2352 by 1568 pixels · 45° FOV
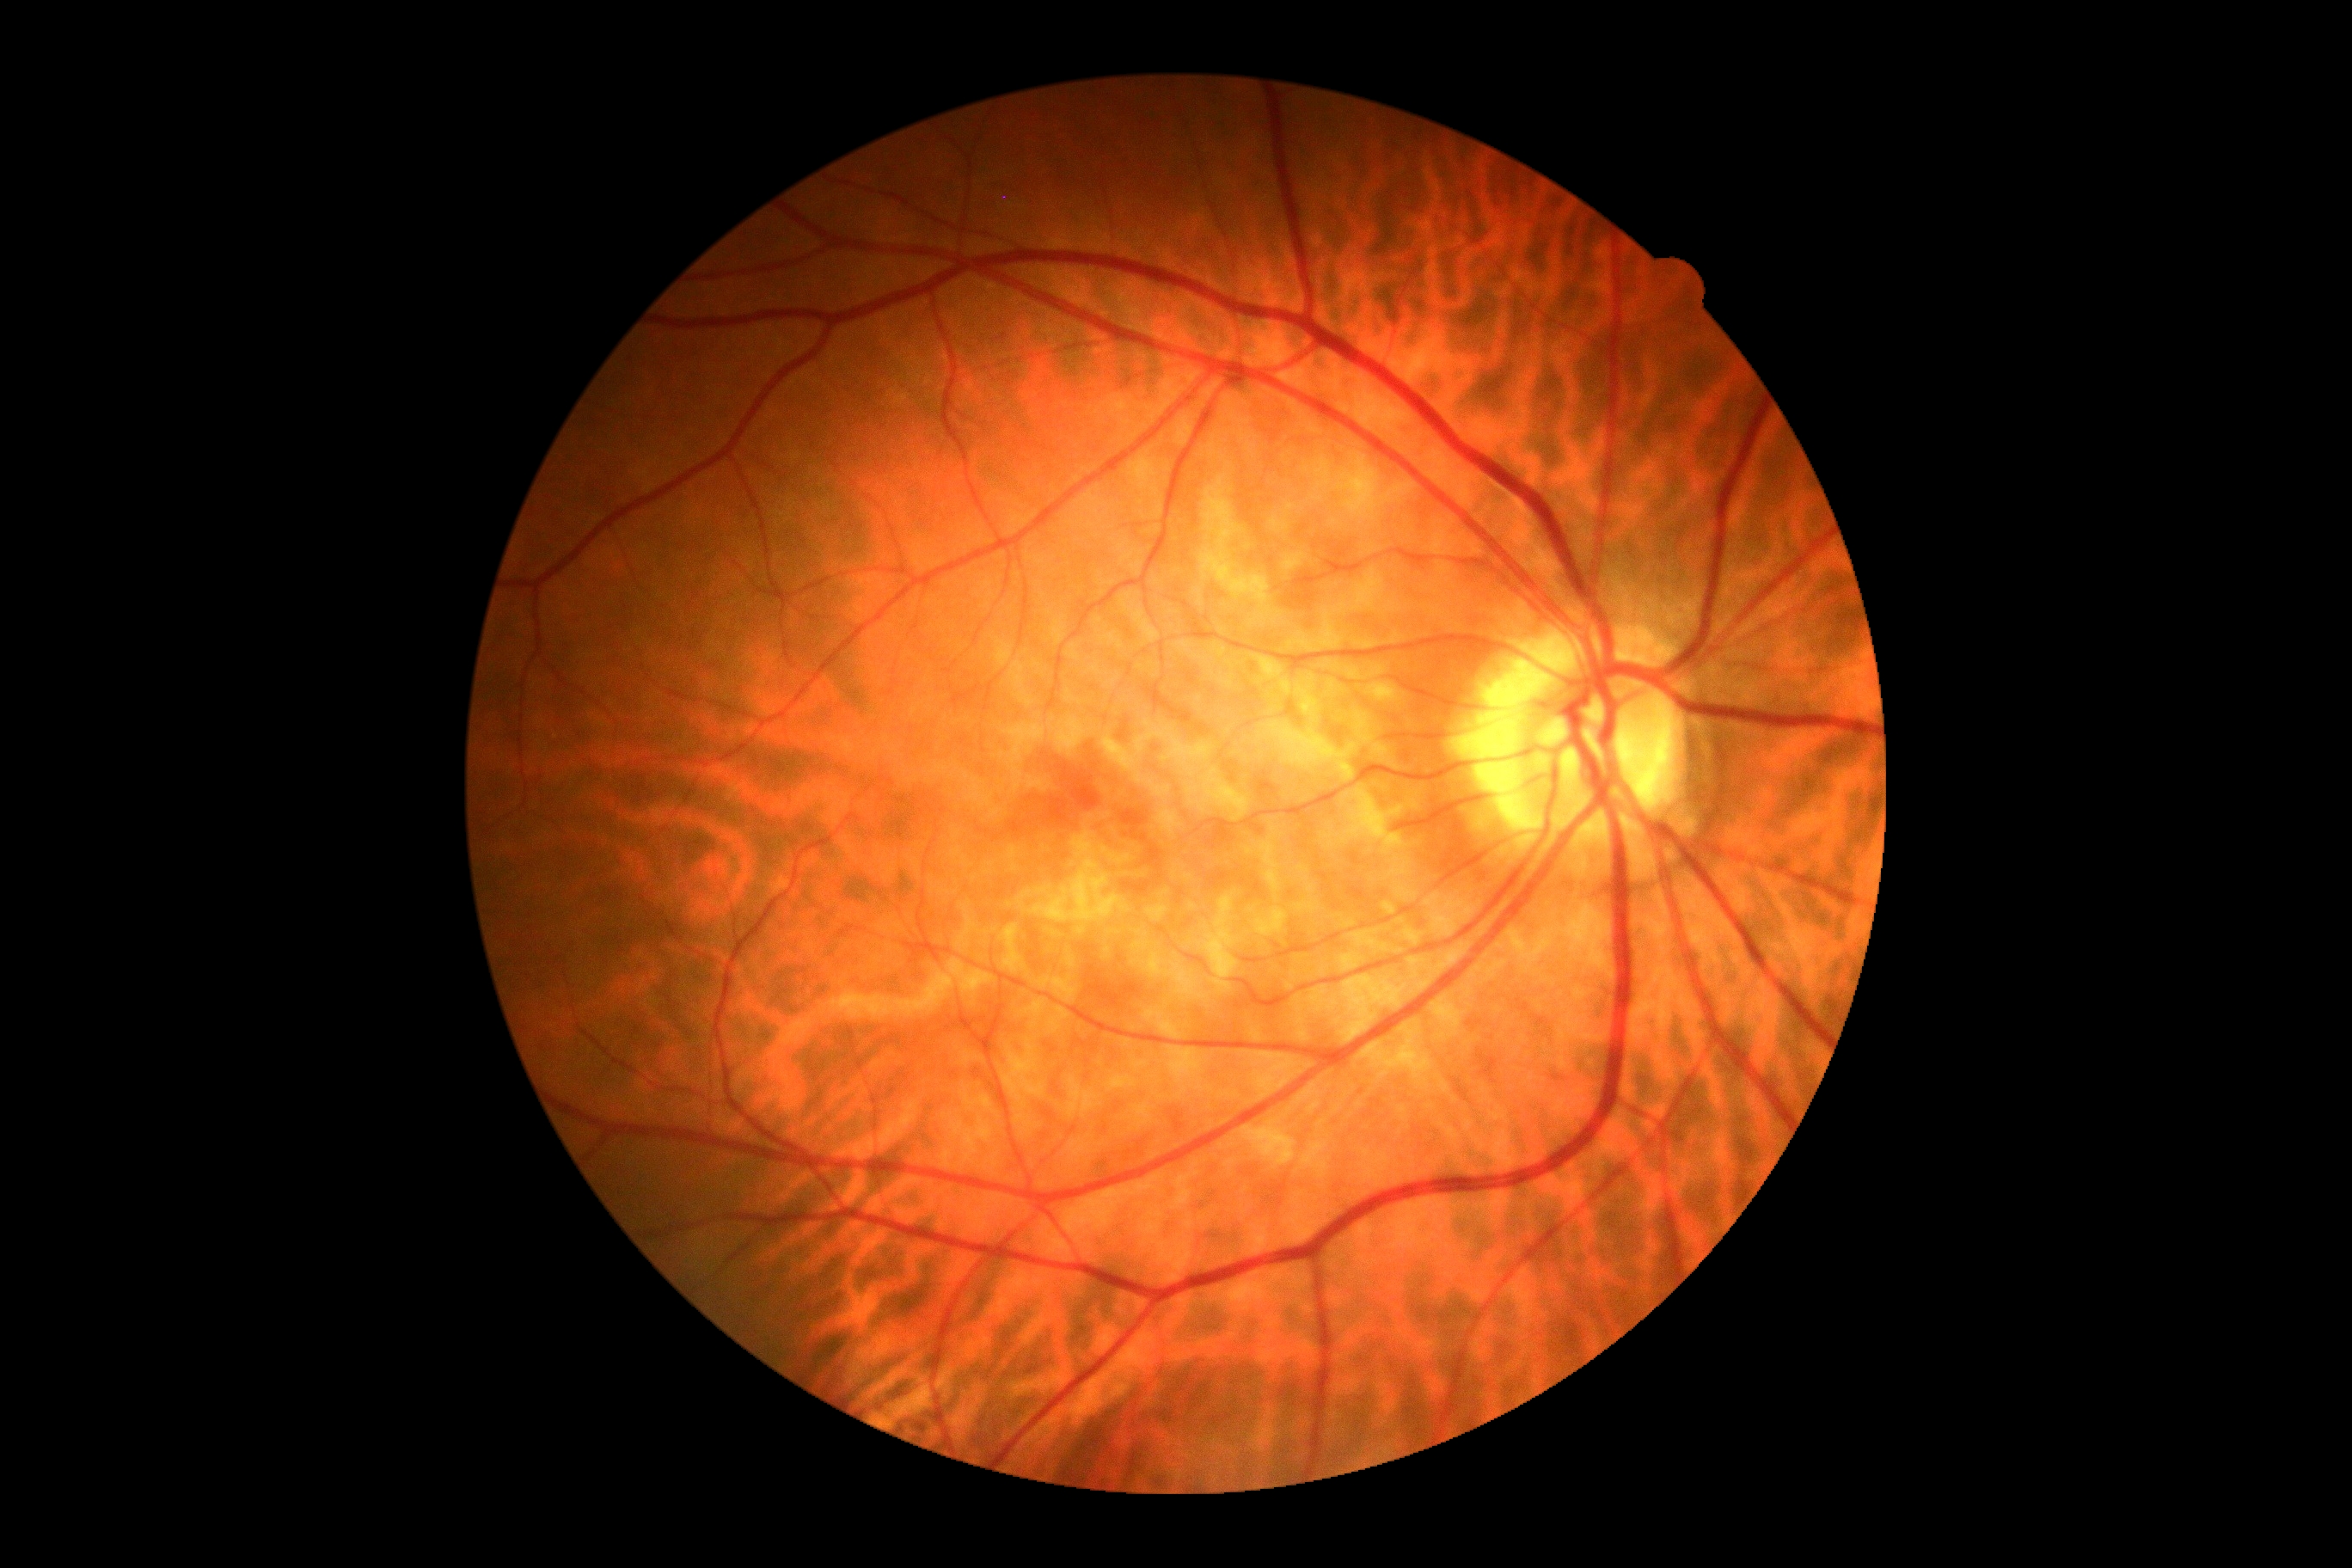

dr_grade: grade 0 (no apparent retinopathy)